Infant wide-field fundus photograph. Camera: Phoenix ICON (100° FOV): 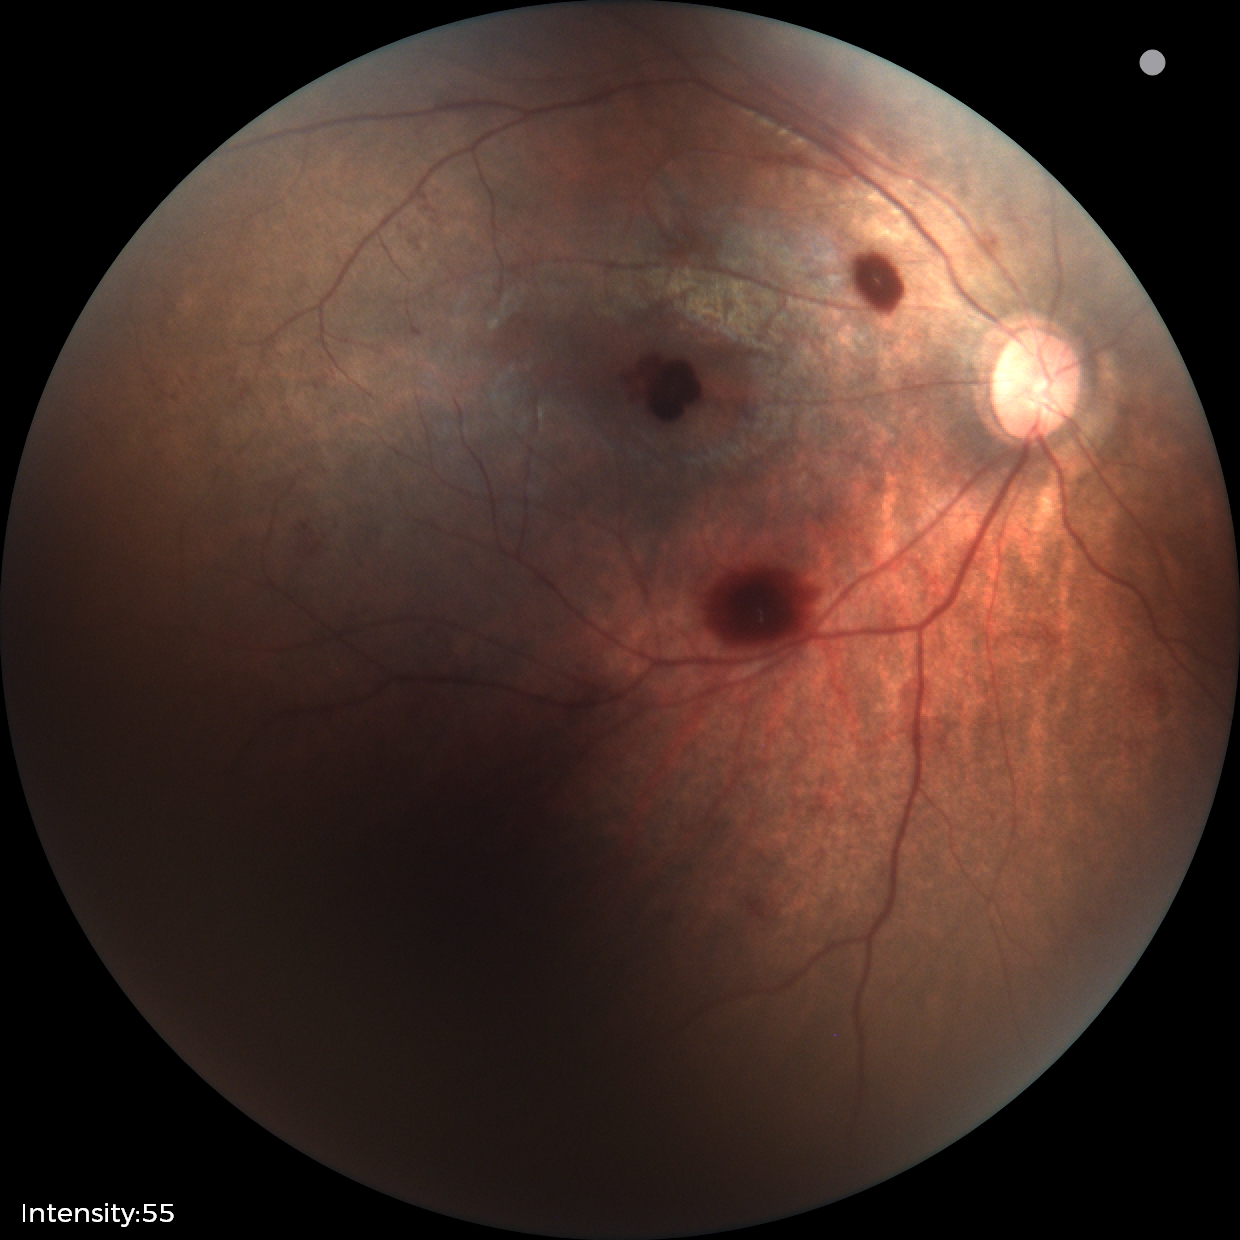

Q: What is the diagnosis from this examination?
A: retinal hemorrhages